45° FOV · camera: NIDEK AFC-230 · 848x848:
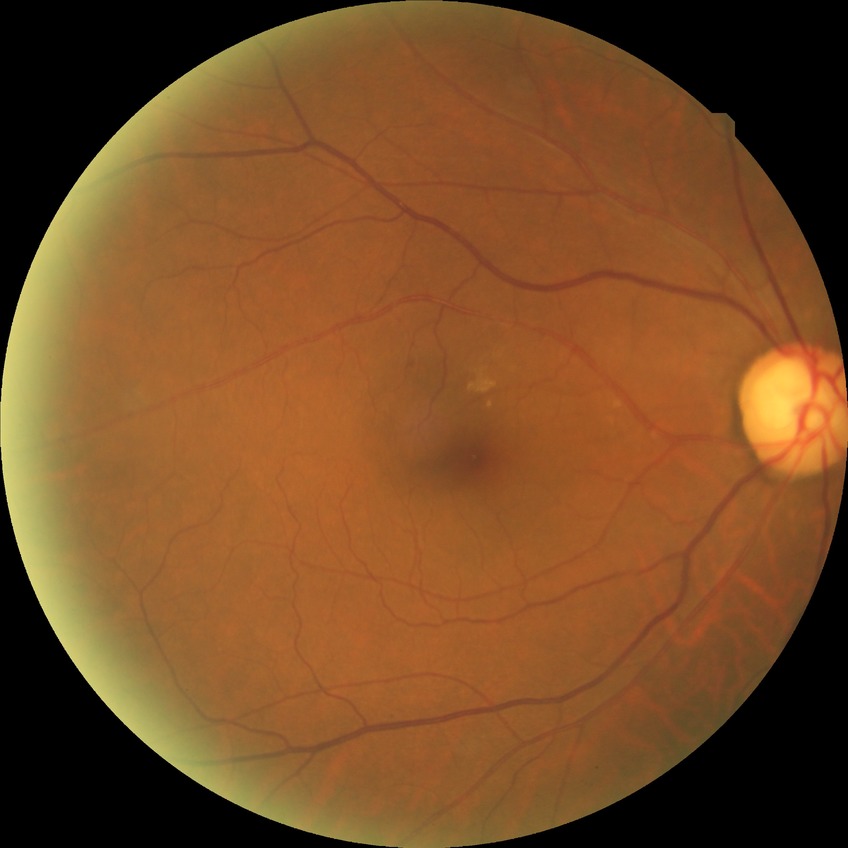 {
  "davis_grade": "NDR",
  "dr_impression": "no signs of DR"
}